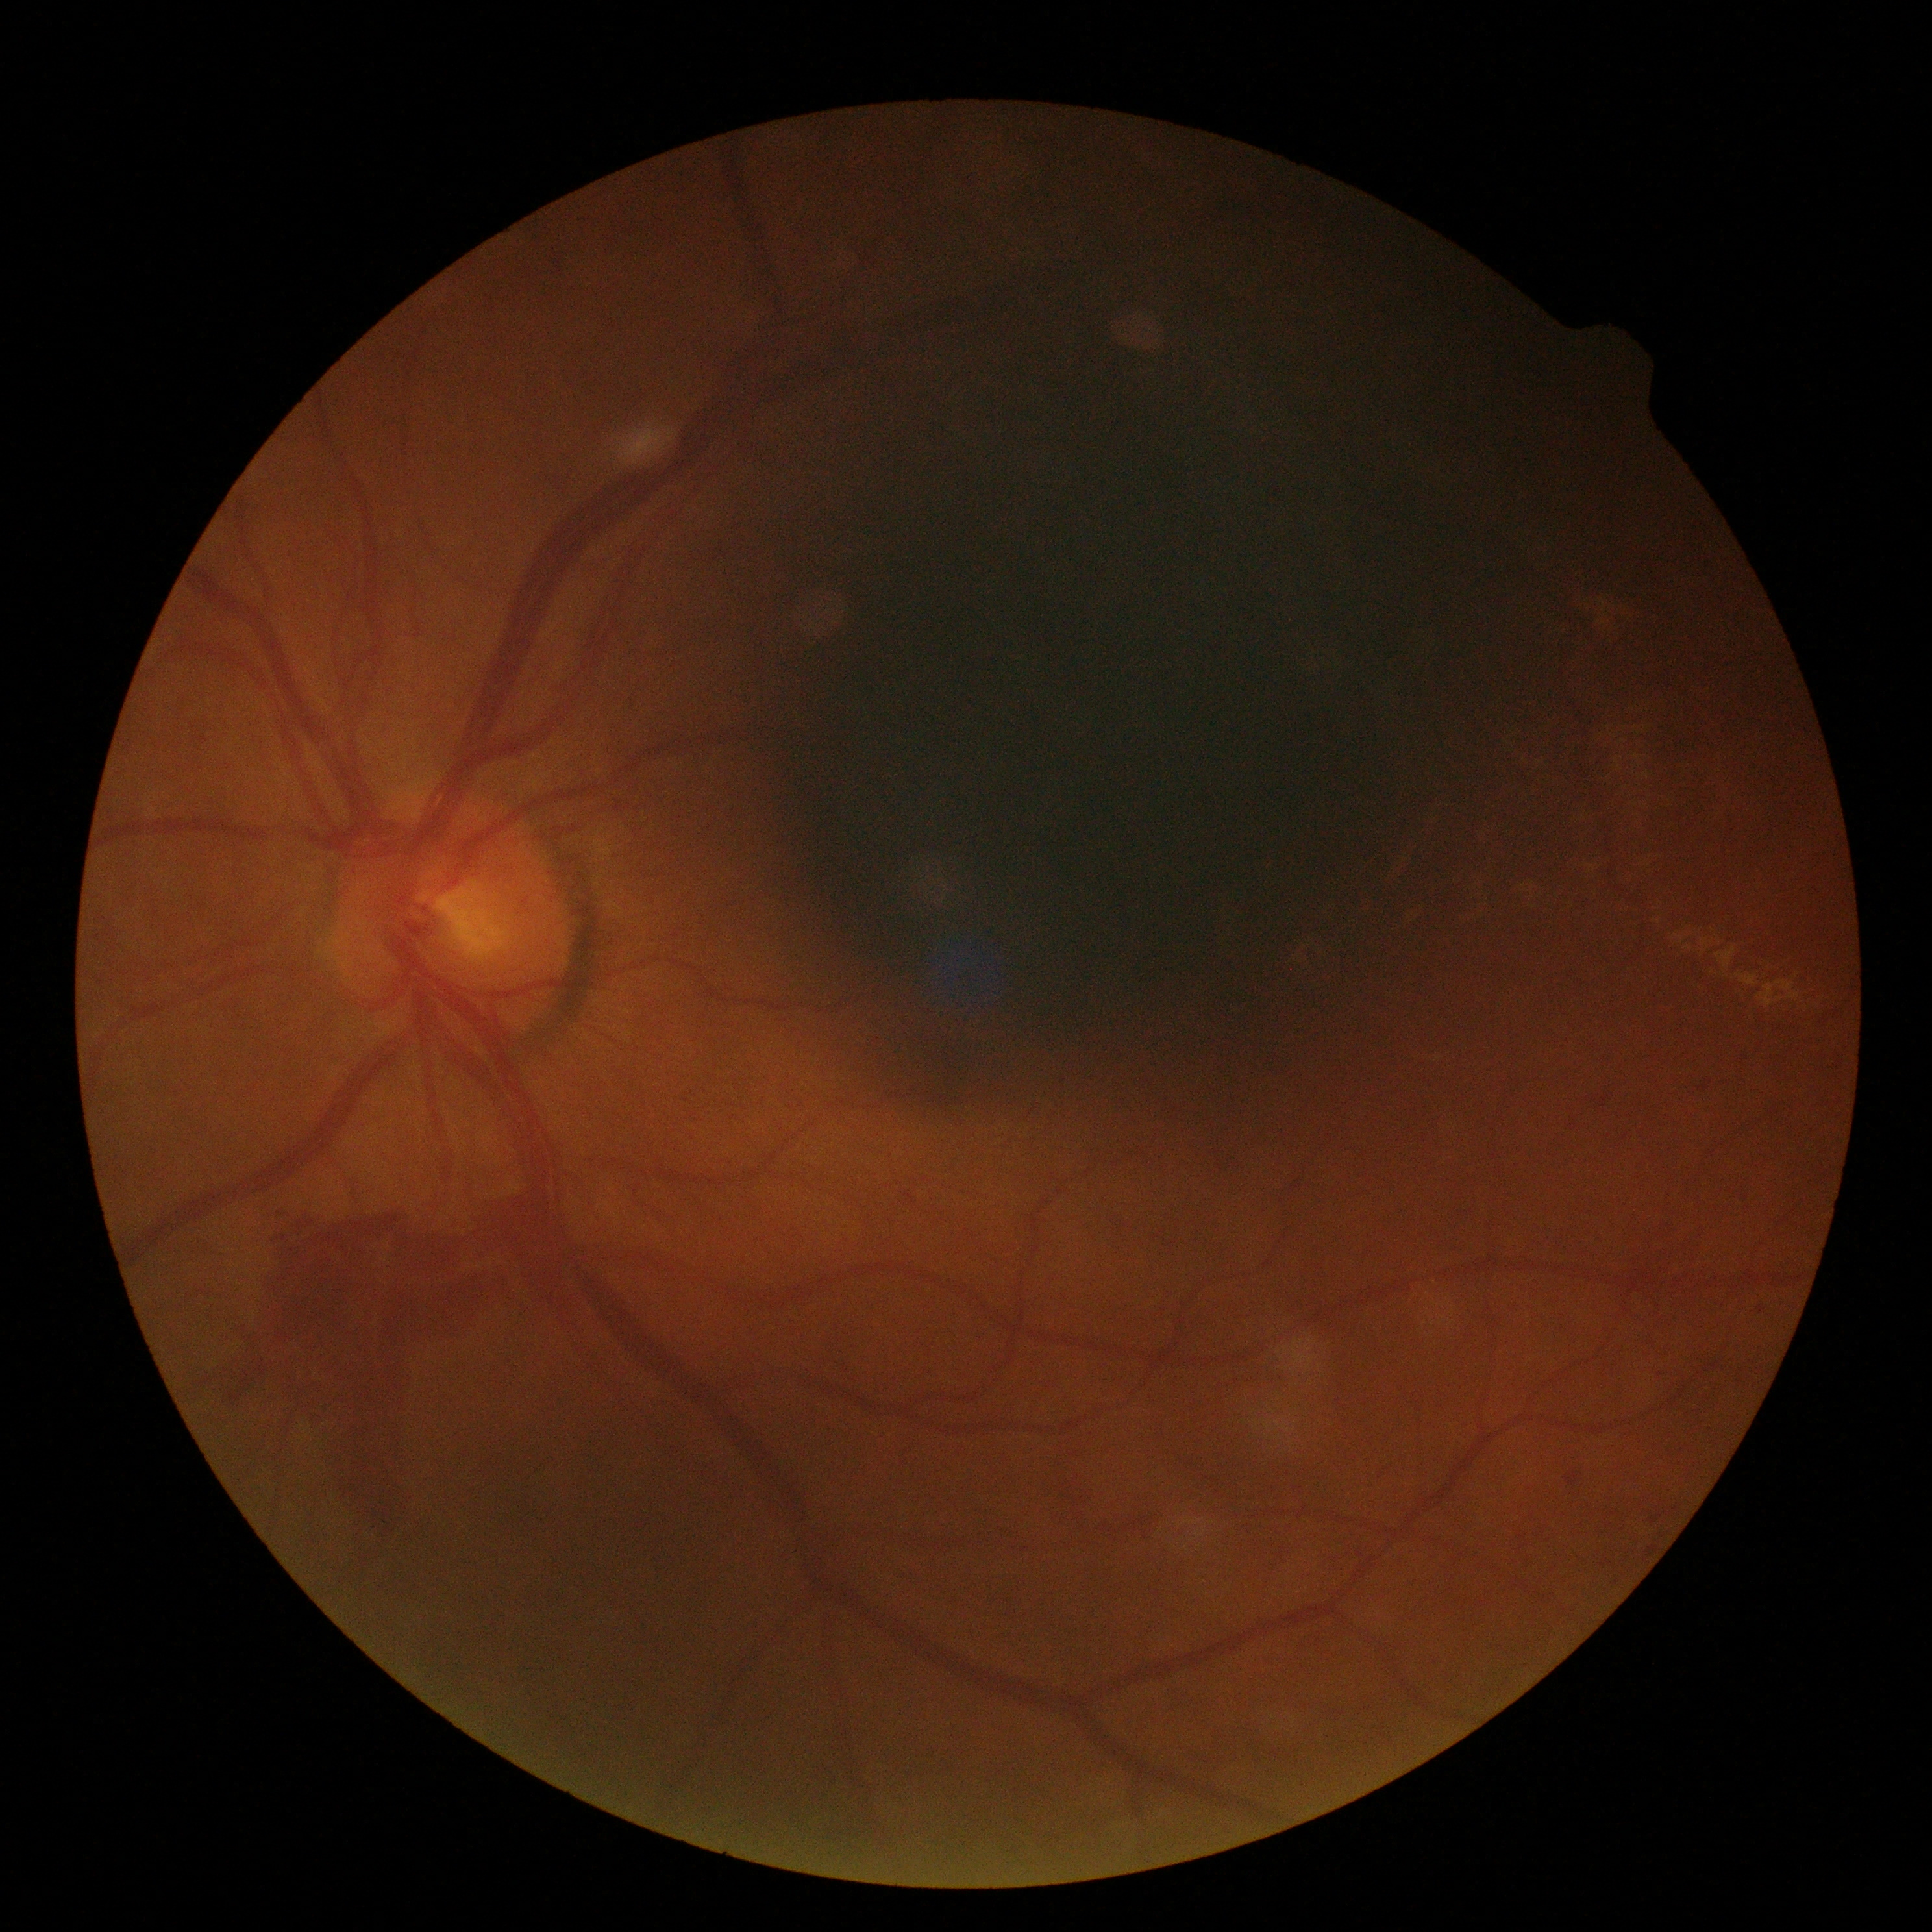 Disease class: proliferative diabetic retinopathy.
Diabetic retinopathy (DR) is proliferative diabetic retinopathy (grade 4) — neovascularization and/or vitreous/pre-retinal hemorrhage.